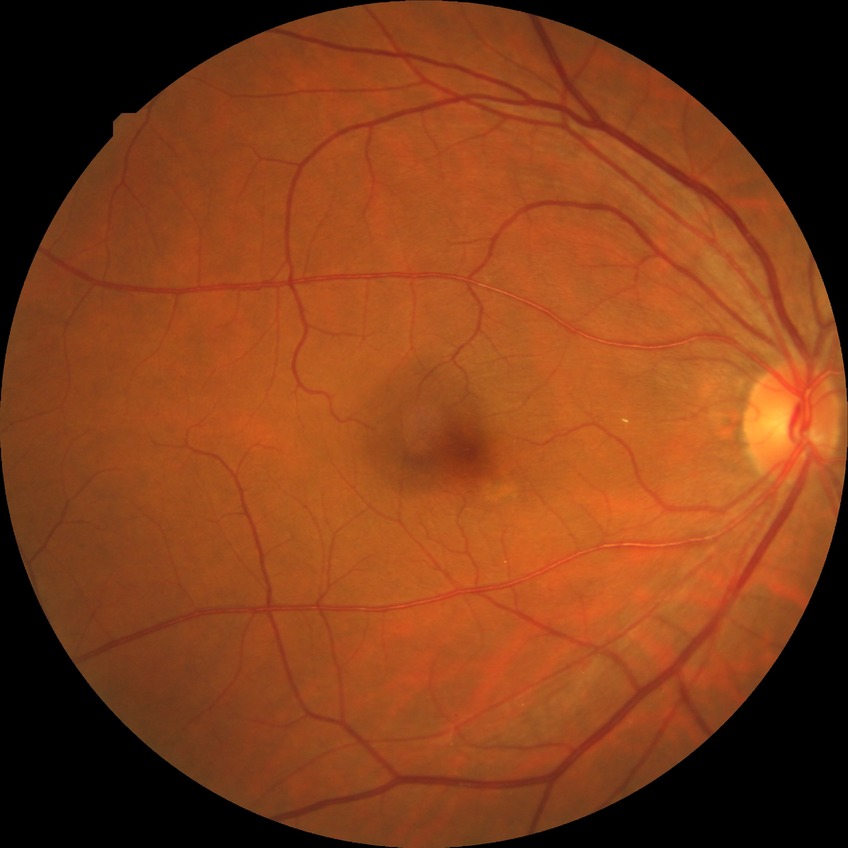 diabetic retinopathy (DR): NDR (no diabetic retinopathy).